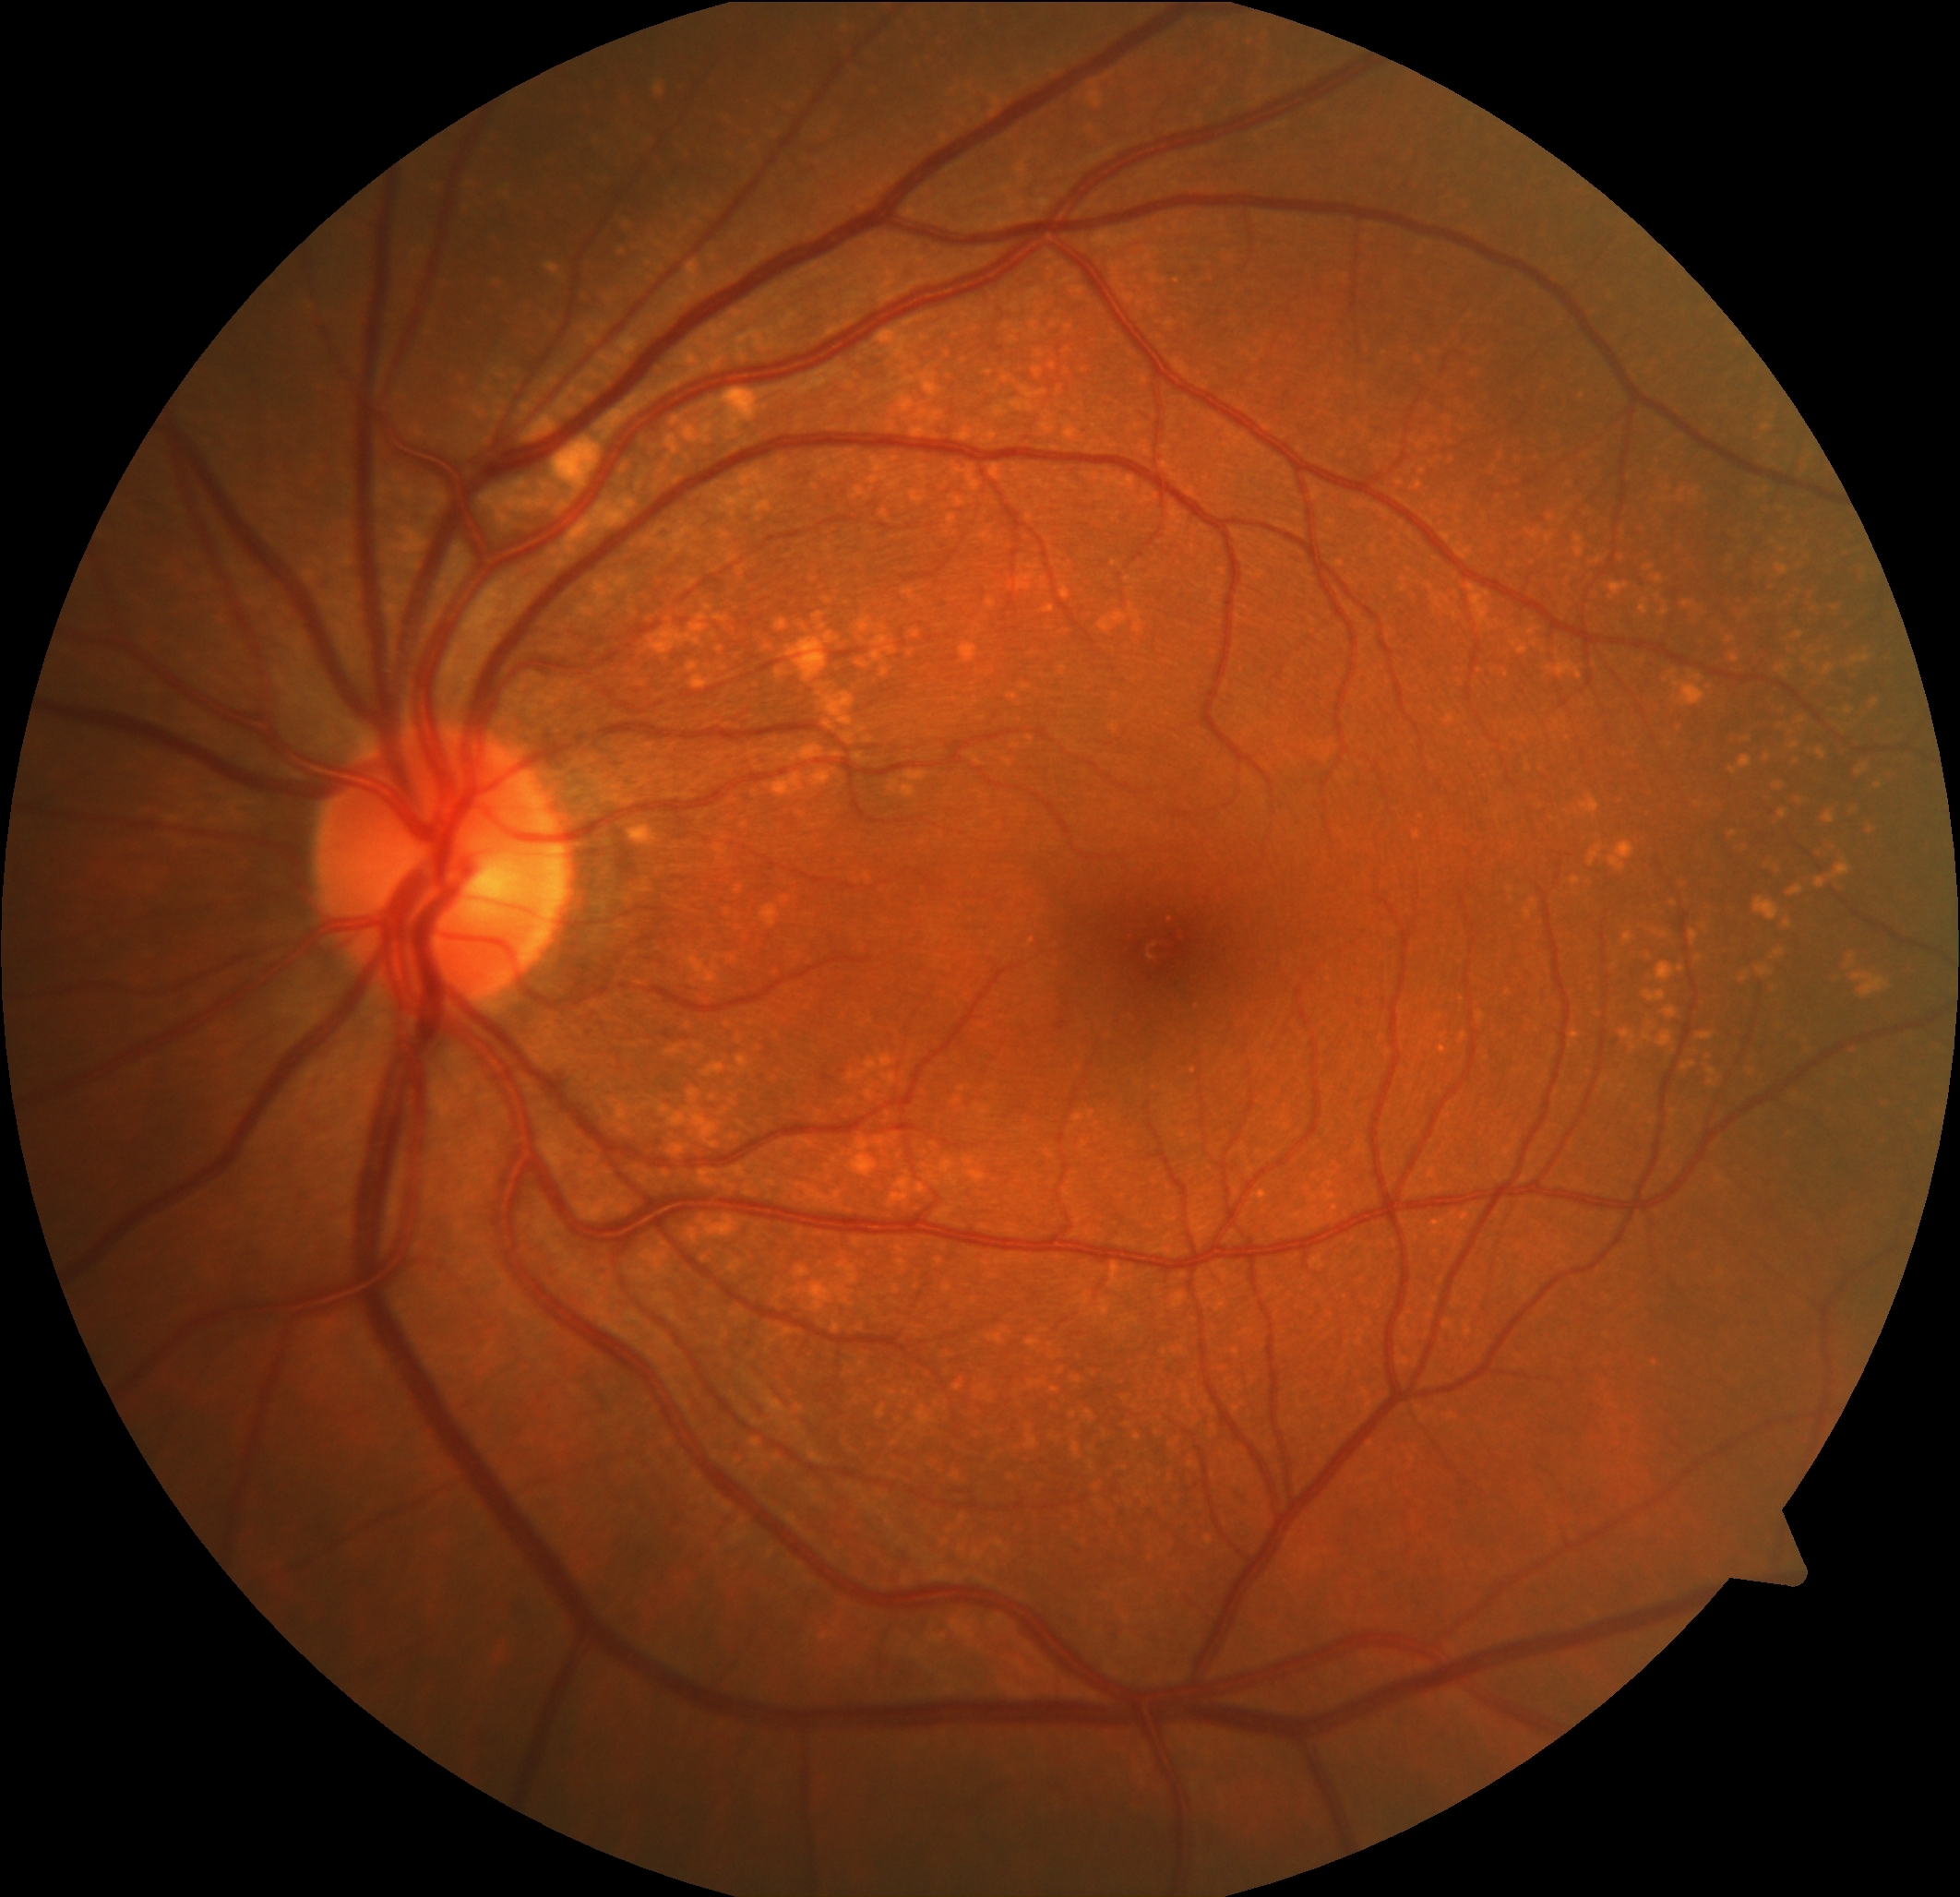

Findings:
• DR severity — grade 0 — no visible signs of diabetic retinopathy